Retinal fundus photograph
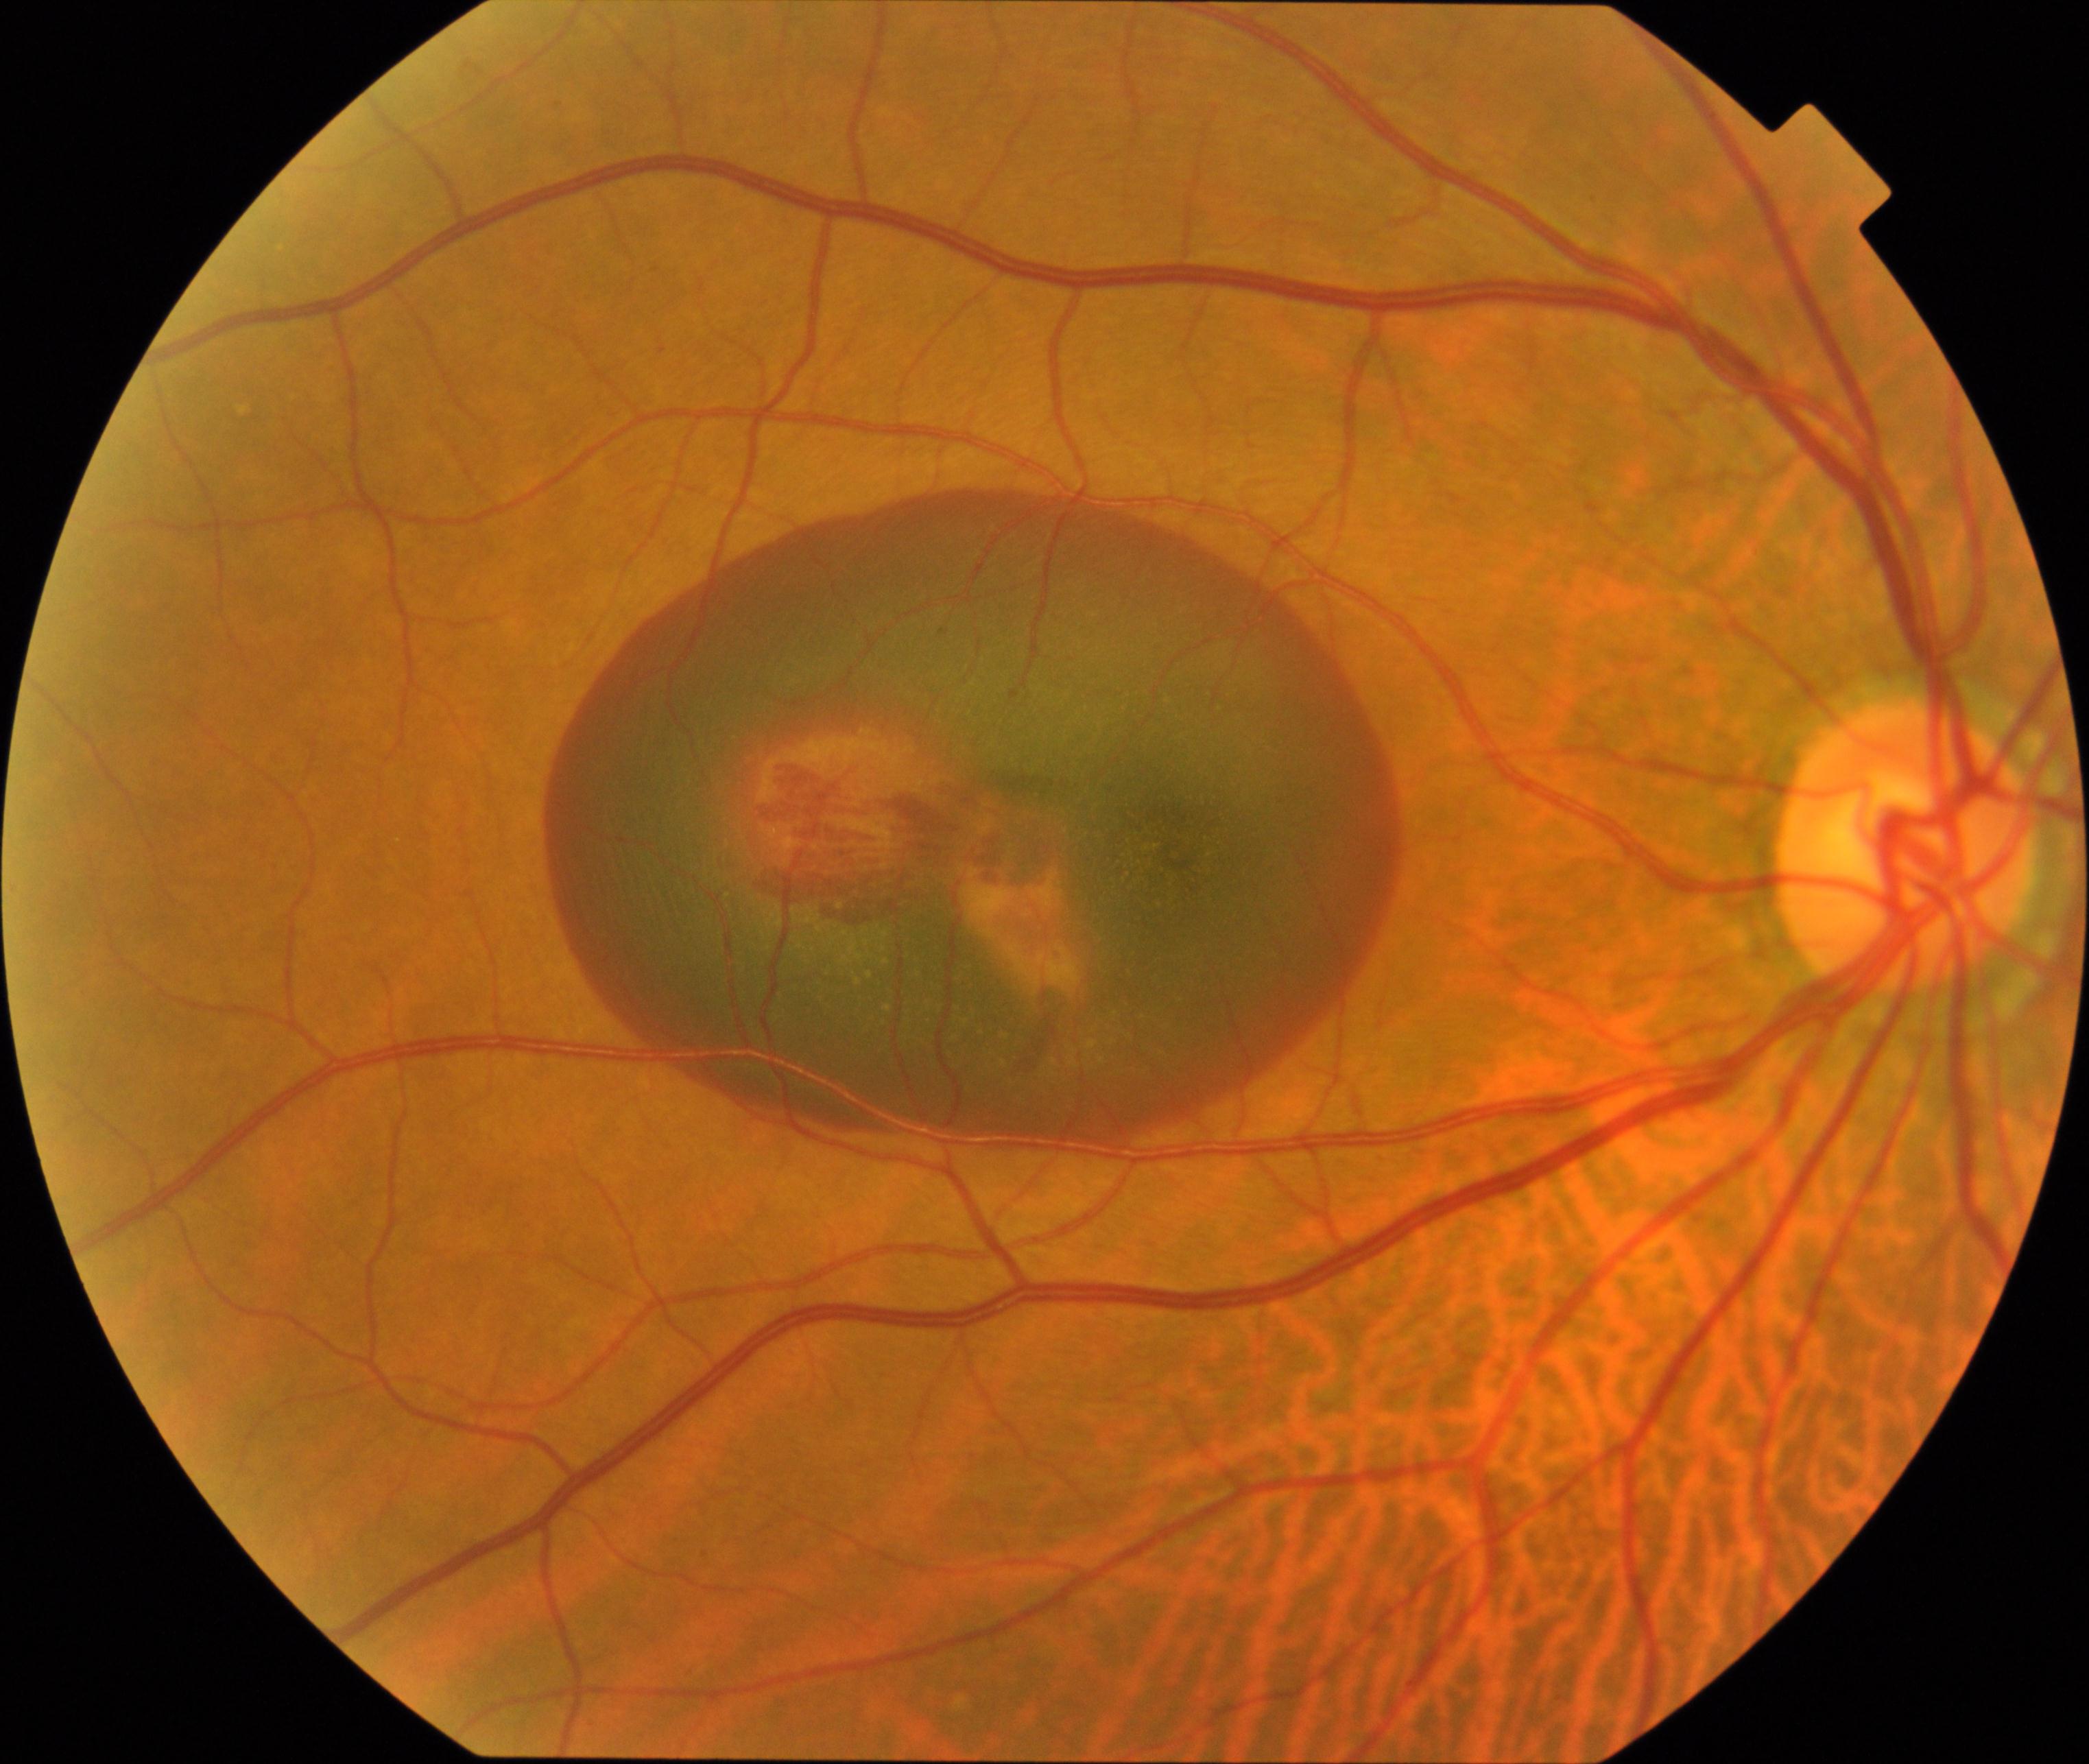
The image shows maculopathy.